Captured on a Nidek AFC-330 fundus camera; 240 x 240 pixels
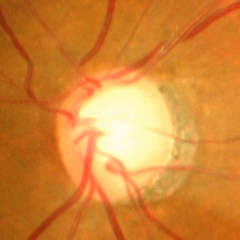

Optic disc appearance consistent with advanced glaucomatous optic neuropathy.